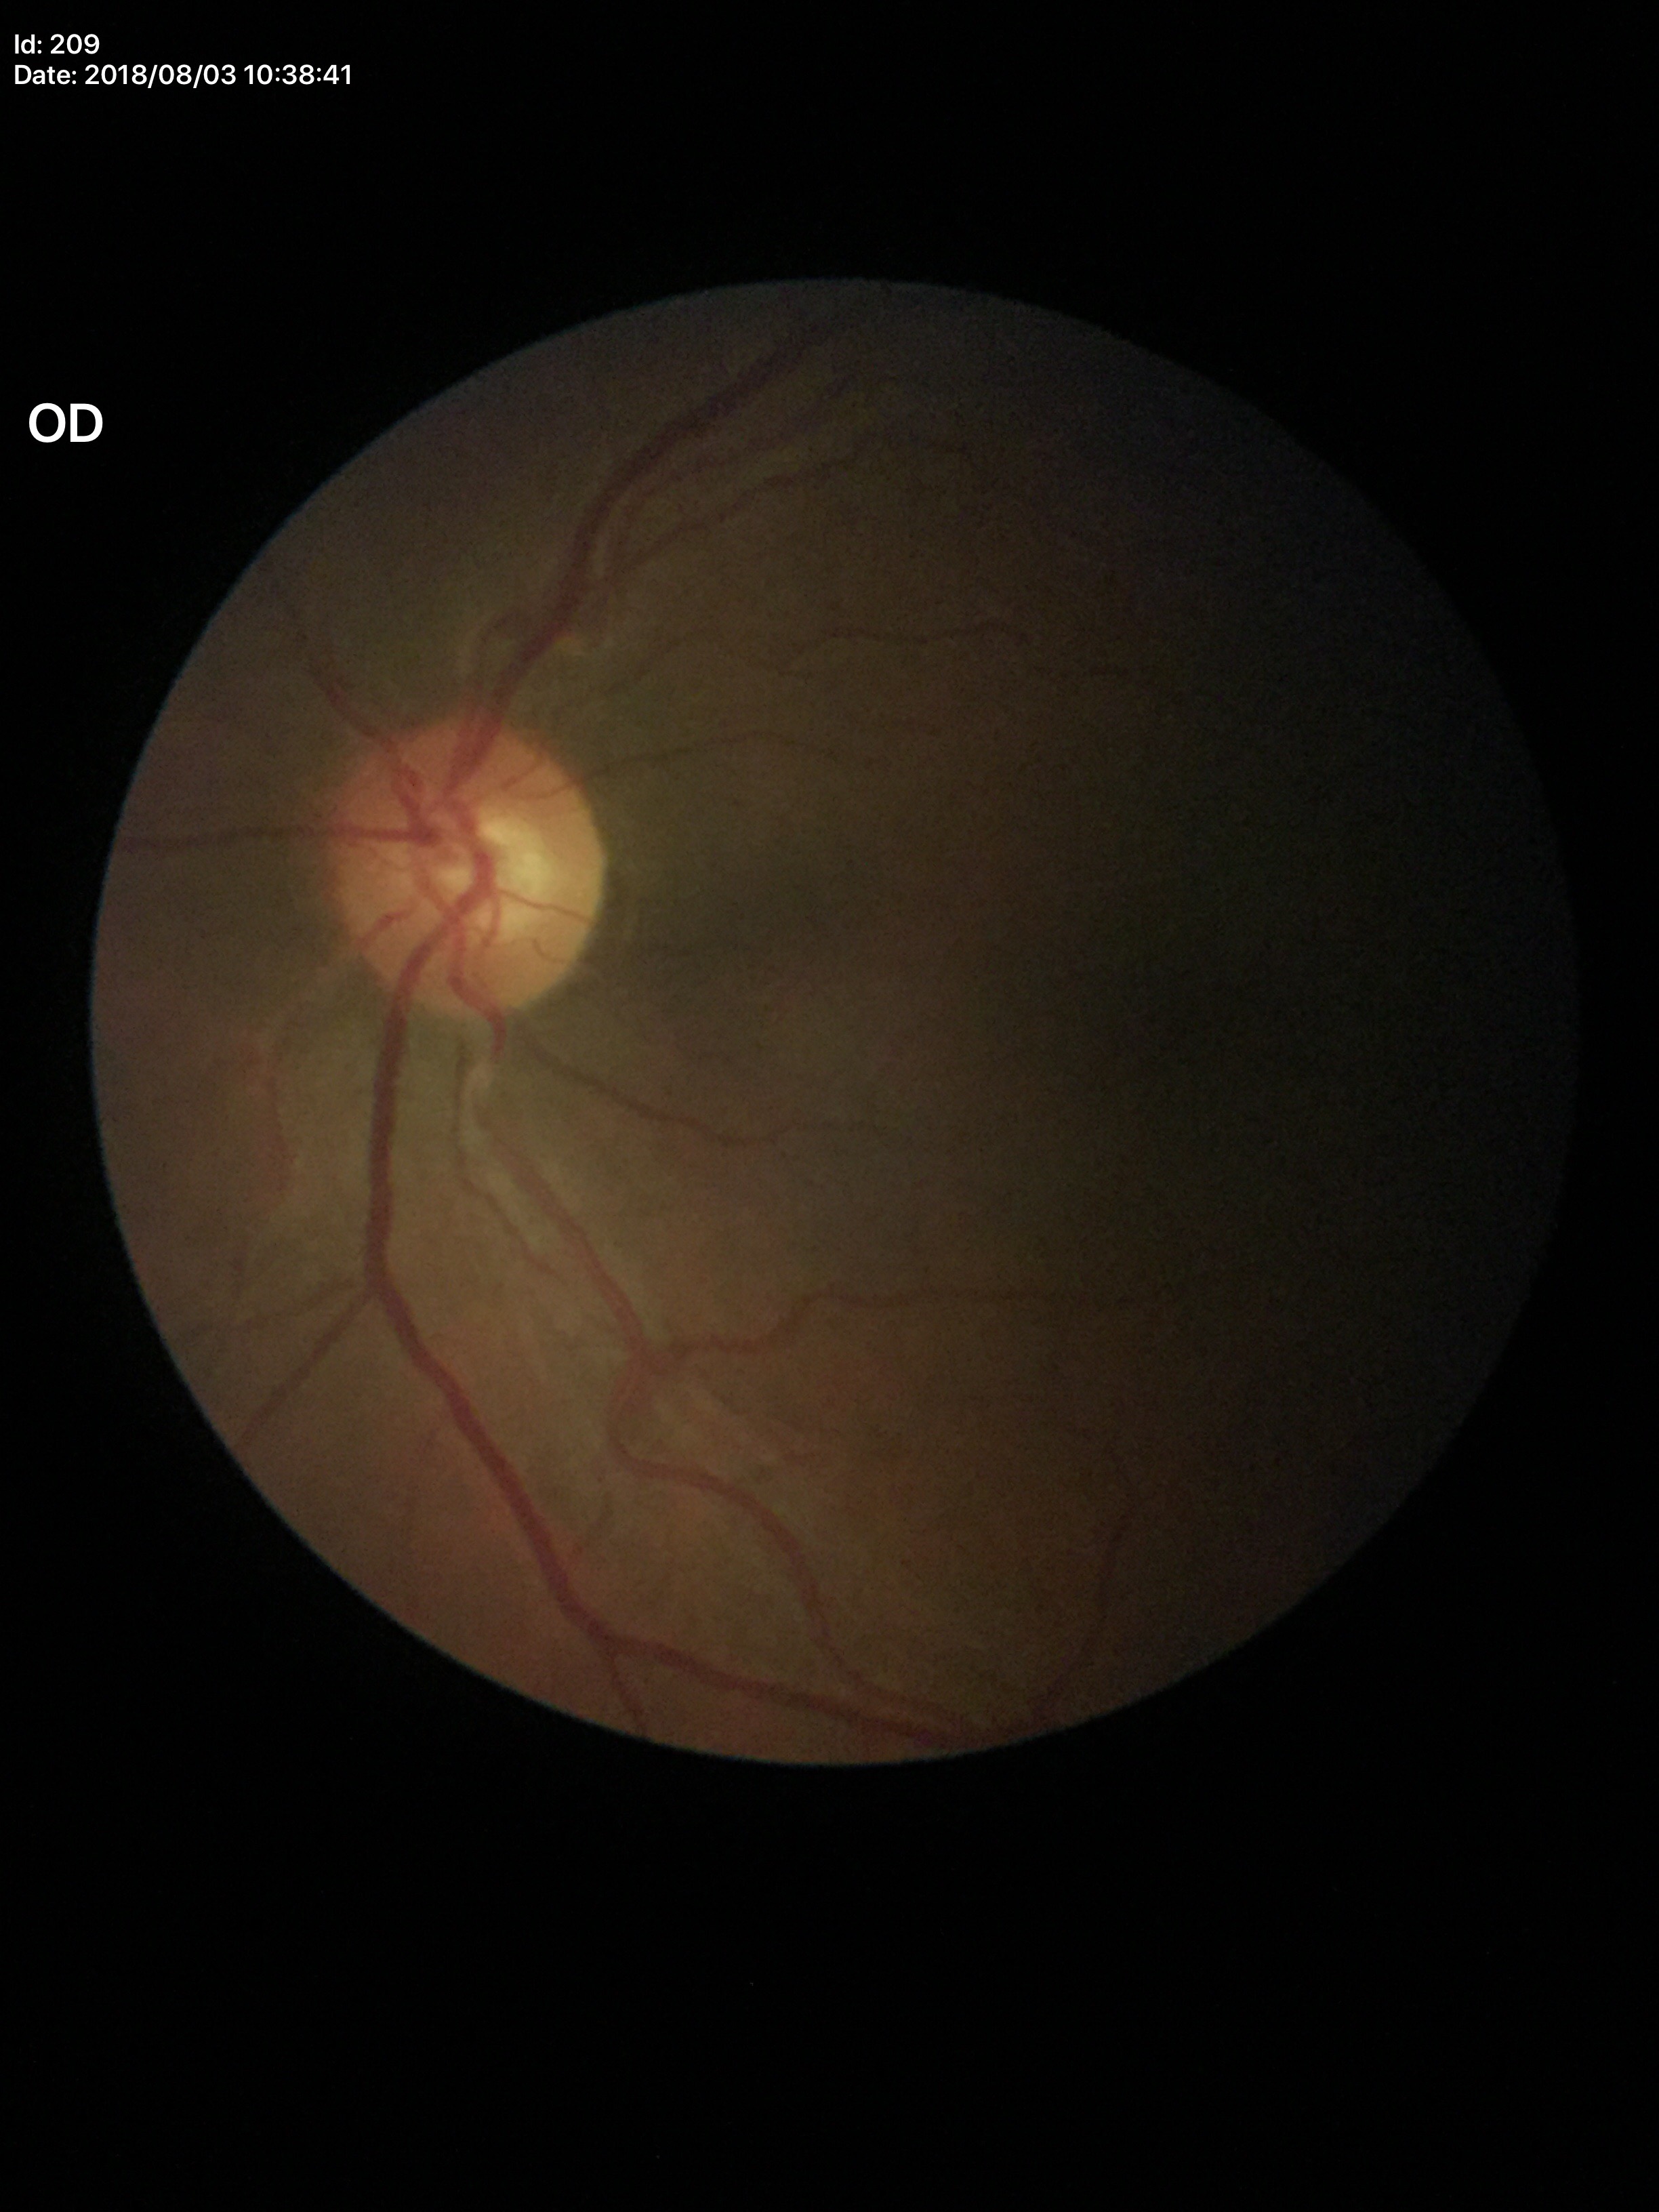
No evidence of glaucoma. Vertical CDR (VCDR) is 0.48. Horizontal cup-to-disc ratio (HCDR): 0.55.